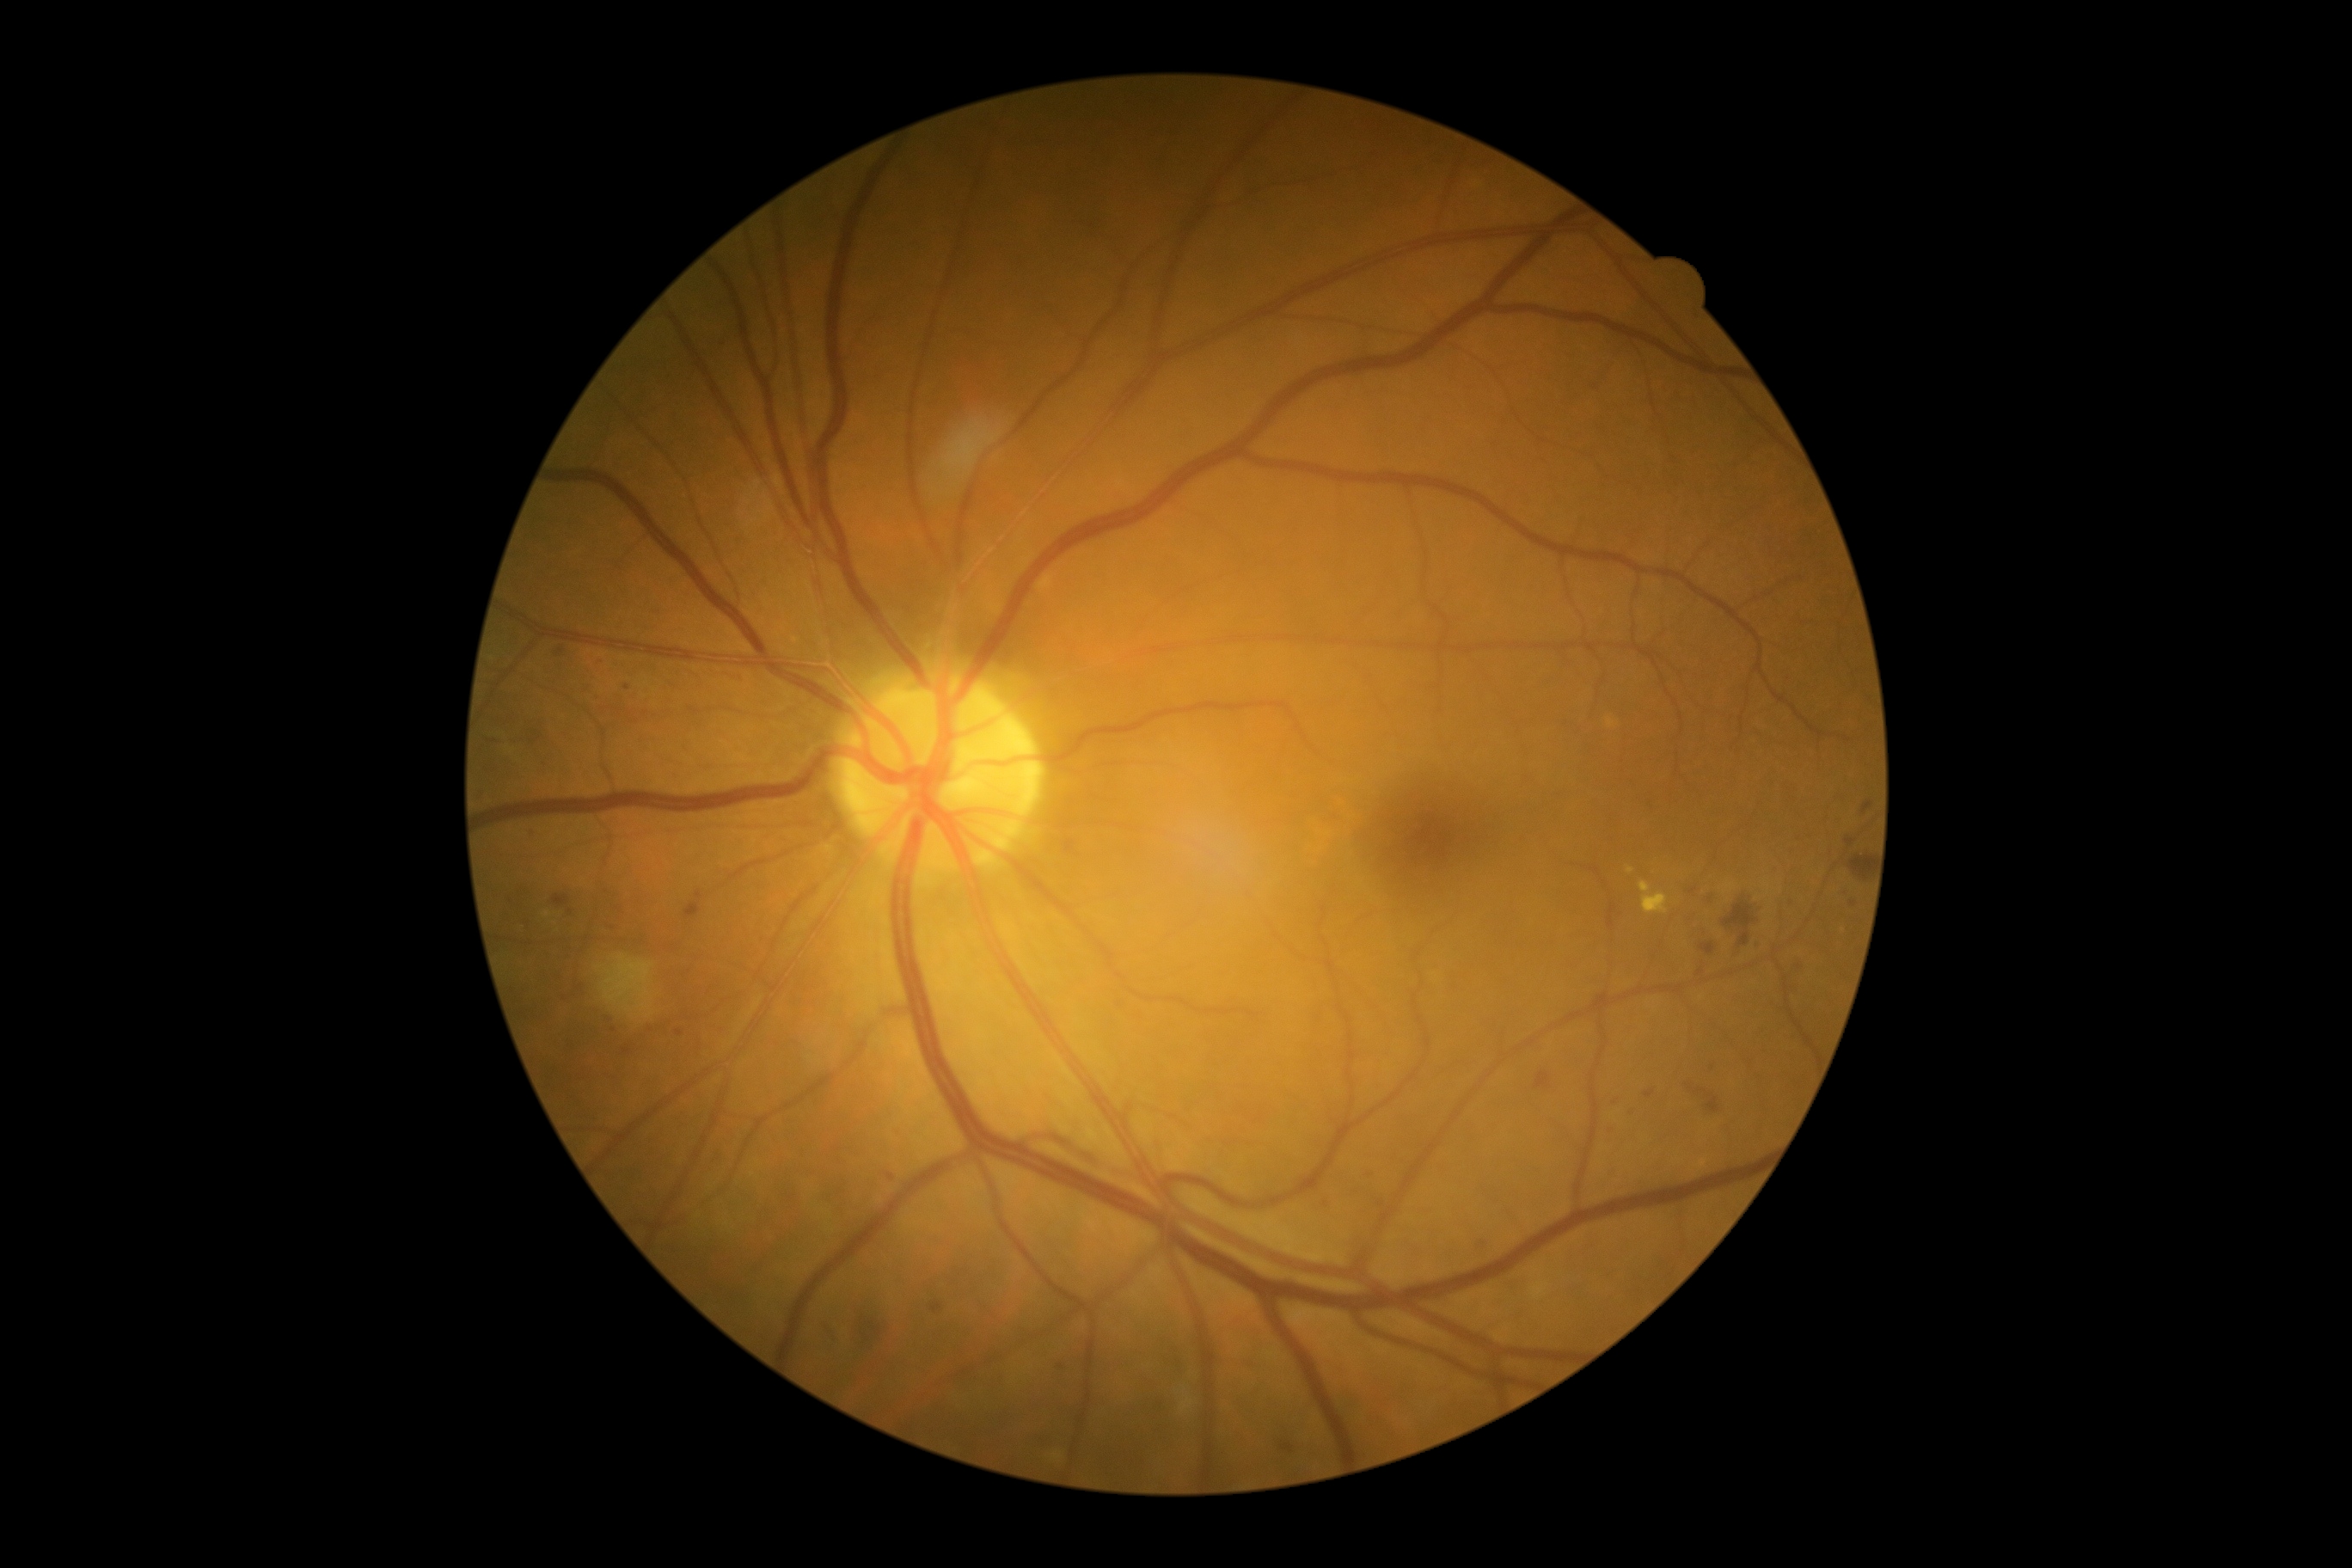

{"partial":true,"dr_grade":2,"dr_grade_name":"moderate NPDR","lesions":{"ma":[[1734,952,1746,959],[481,793,484,802],[1755,903,1767,909],[606,924,615,933],[675,1029,683,1036],[886,1173,895,1180],[1473,1240,1490,1254],[1624,1110,1632,1118],[931,1304,943,1313],[606,1019,615,1024],[1645,1091,1655,1099]],"ma_small":[[614,1029],[1061,1367],[1713,1068]]}}